Mydriatic (tropicamide and phenylephrine), central posterior field, 50° field of view, acquired with a Topcon TRC-50DX, fundus photo:
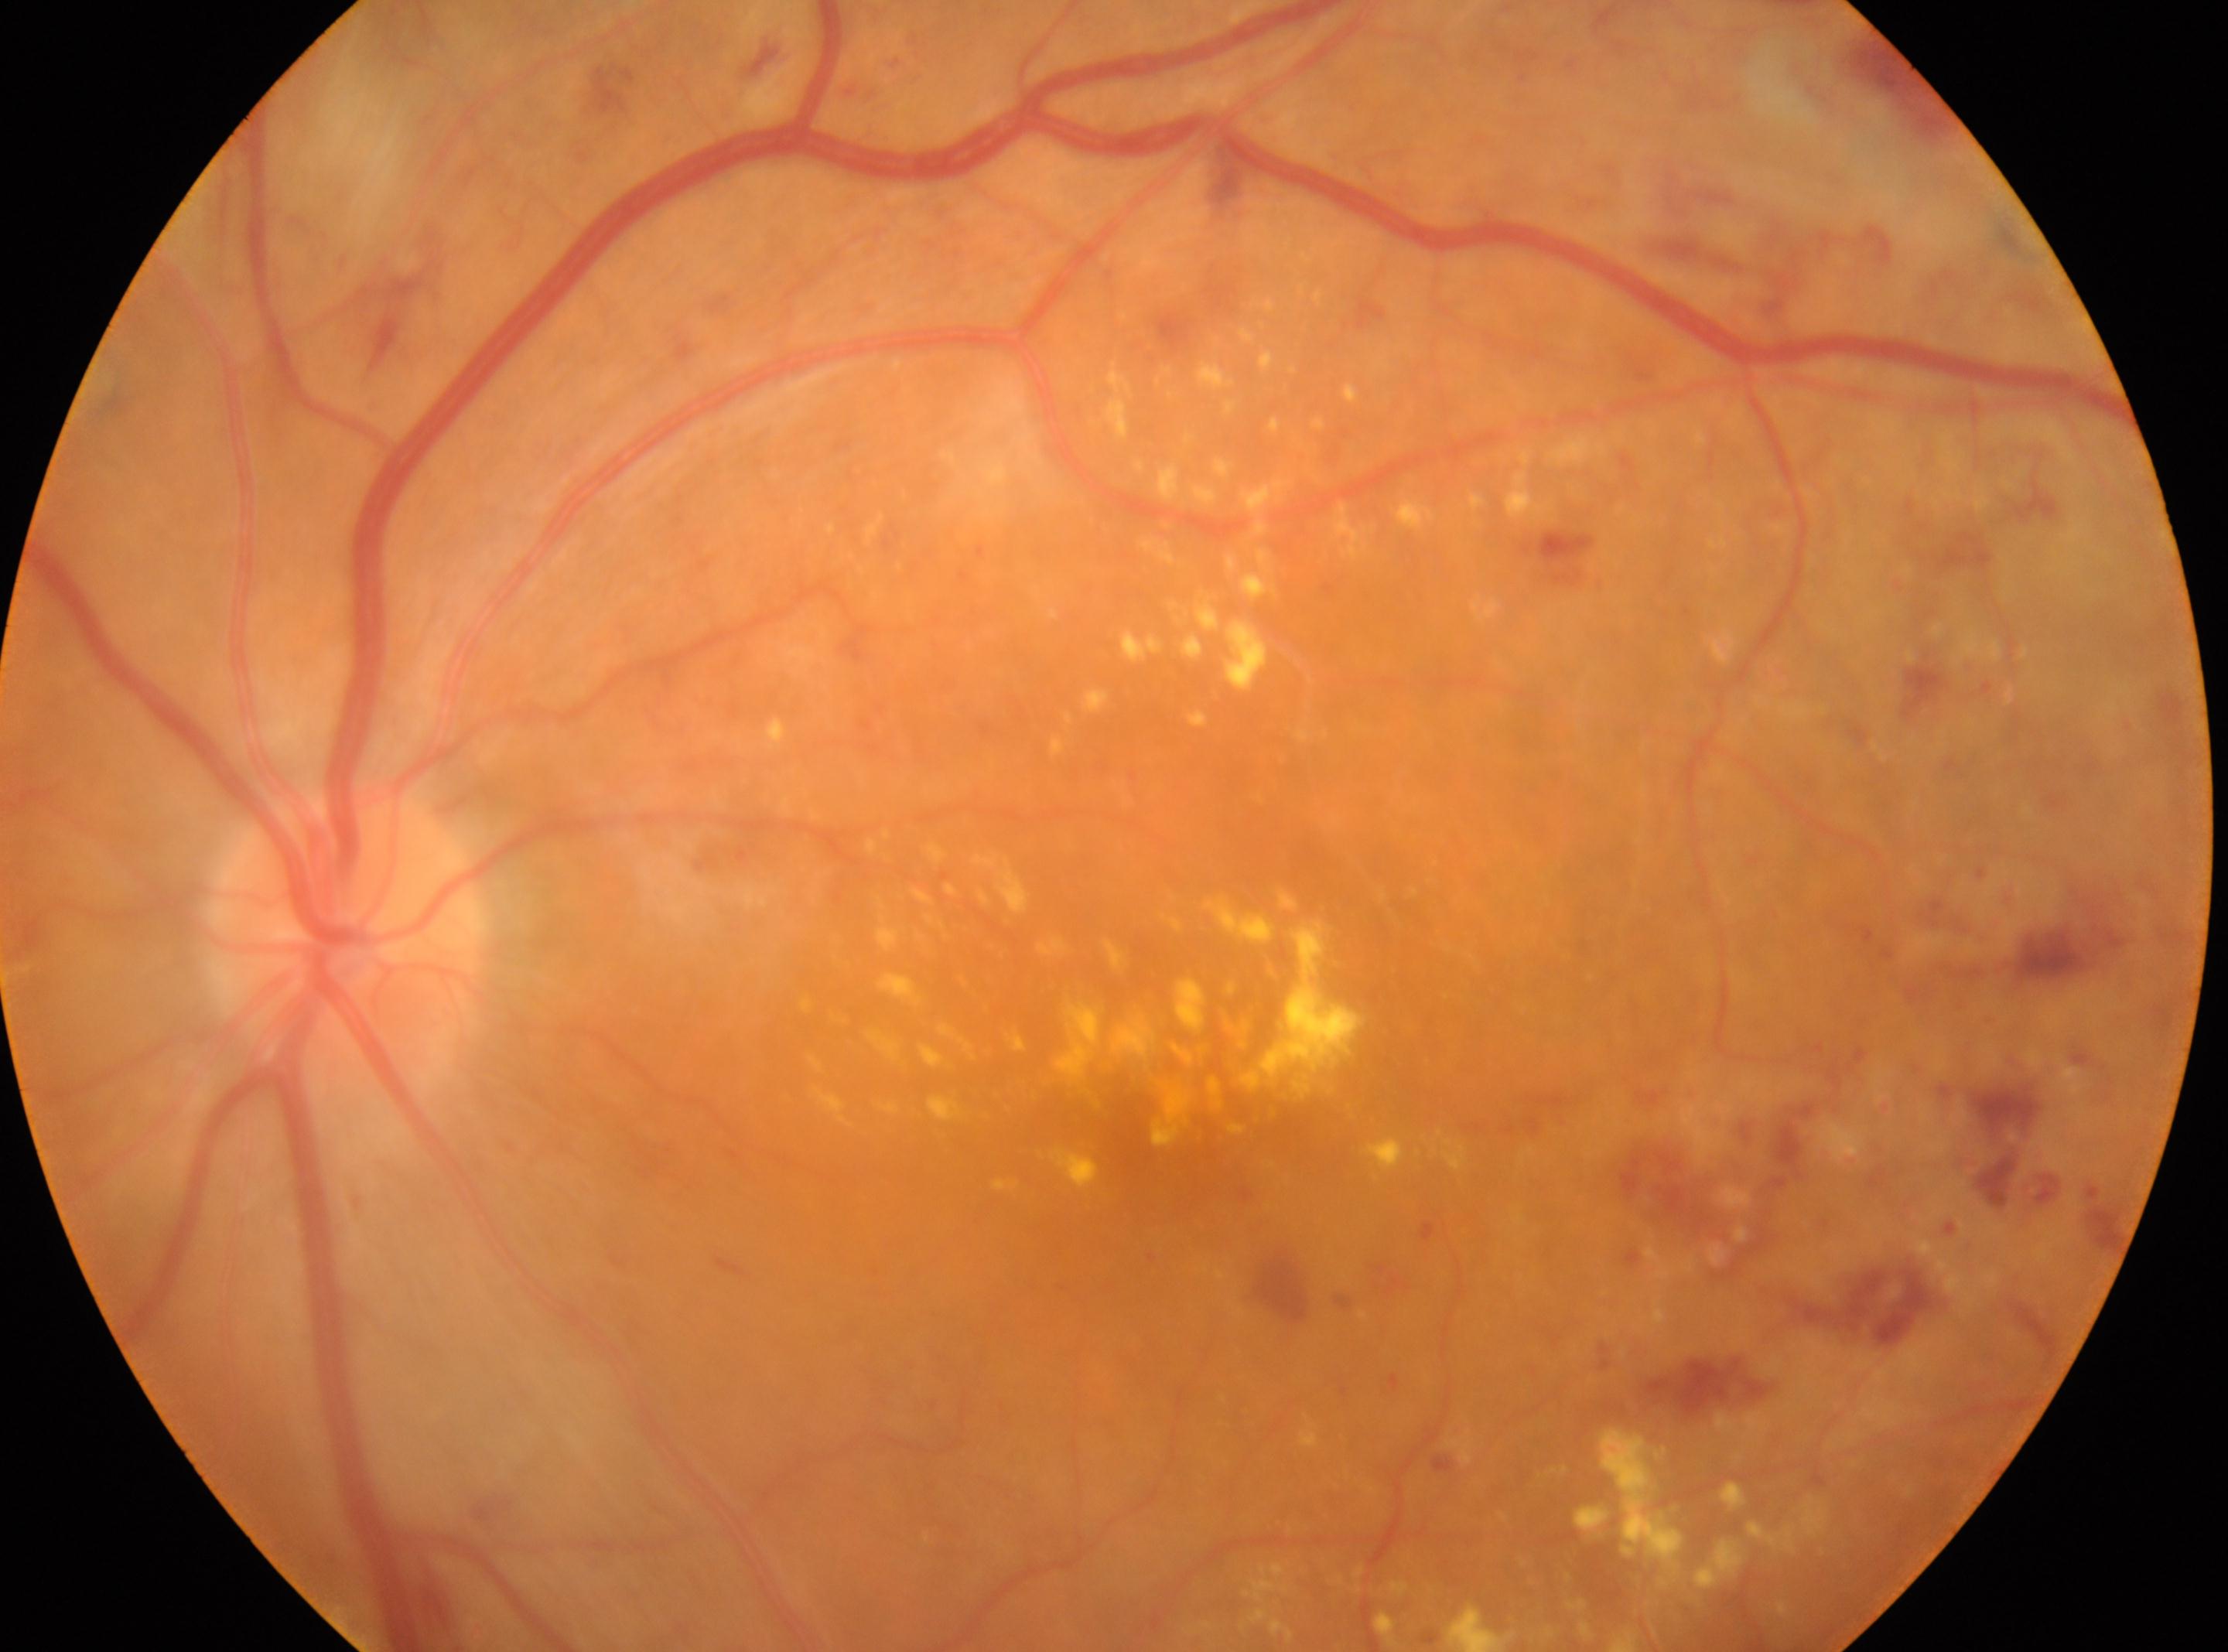
Eye: oculus sinister. Optic disc center: (345,943). DR grade is 3 — more than 20 intraretinal hemorrhages in each of 4 quadrants, definite venous beading in 2 or more quadrants, or prominent intraretinal microvascular abnormalities in 1 or more quadrants, with no signs of proliferative retinopathy. Foveal center: (1146,1128).